Pediatric wide-field fundus photograph; 1240 x 1240 pixels.
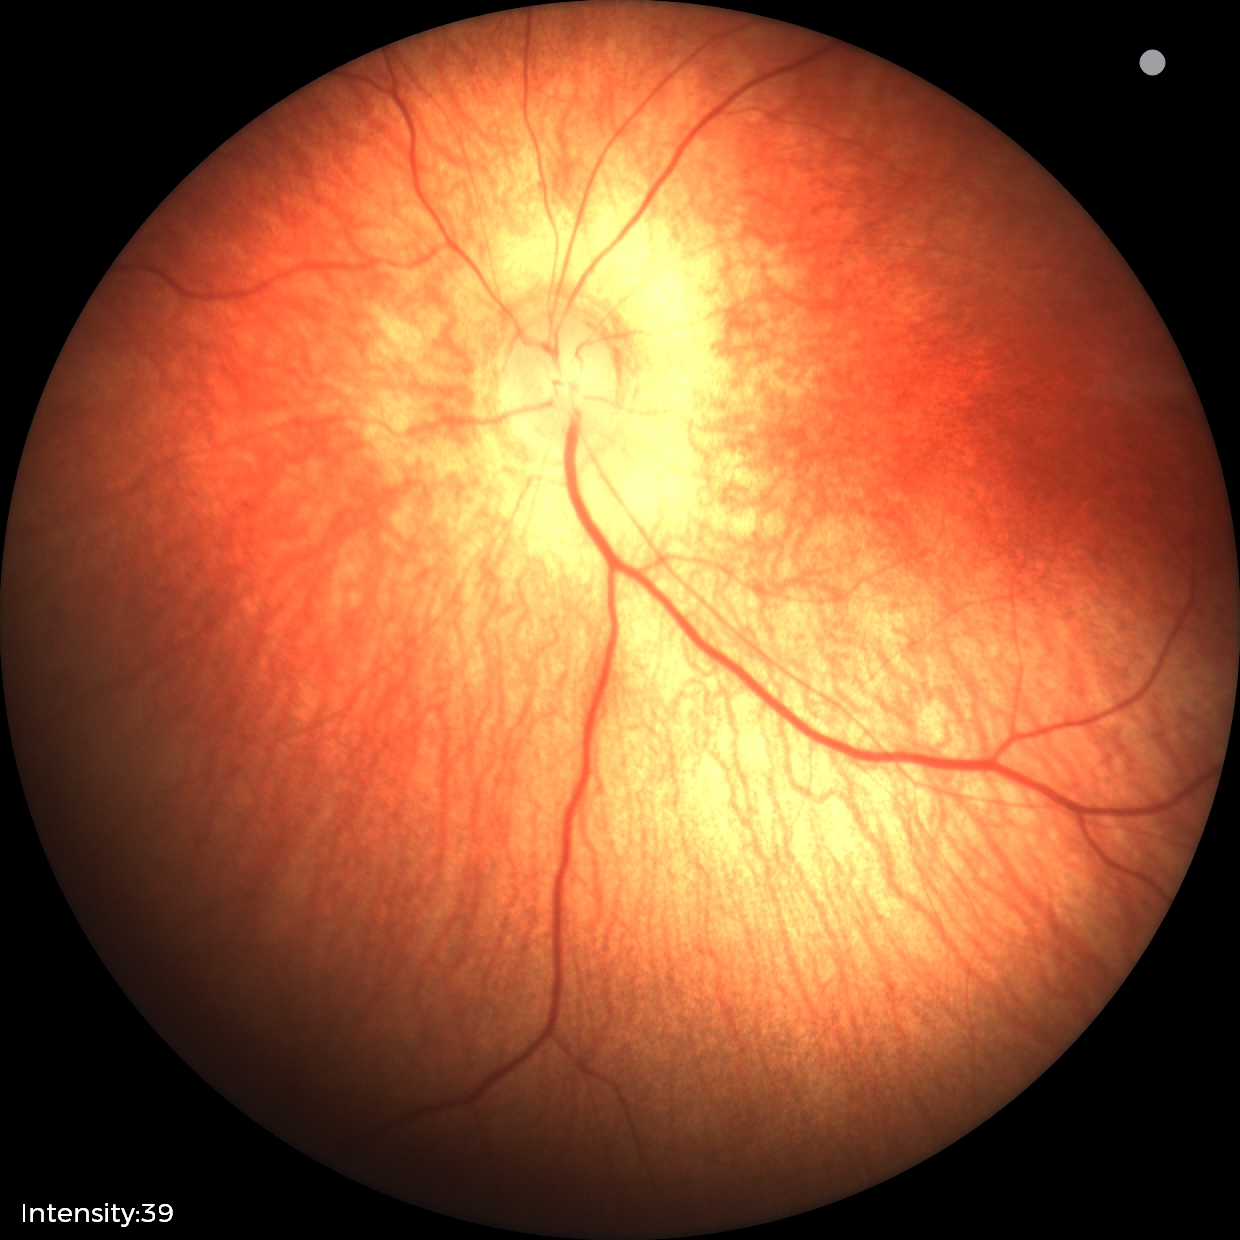 Finding: physiological appearance.